45° field of view · fundus photo: 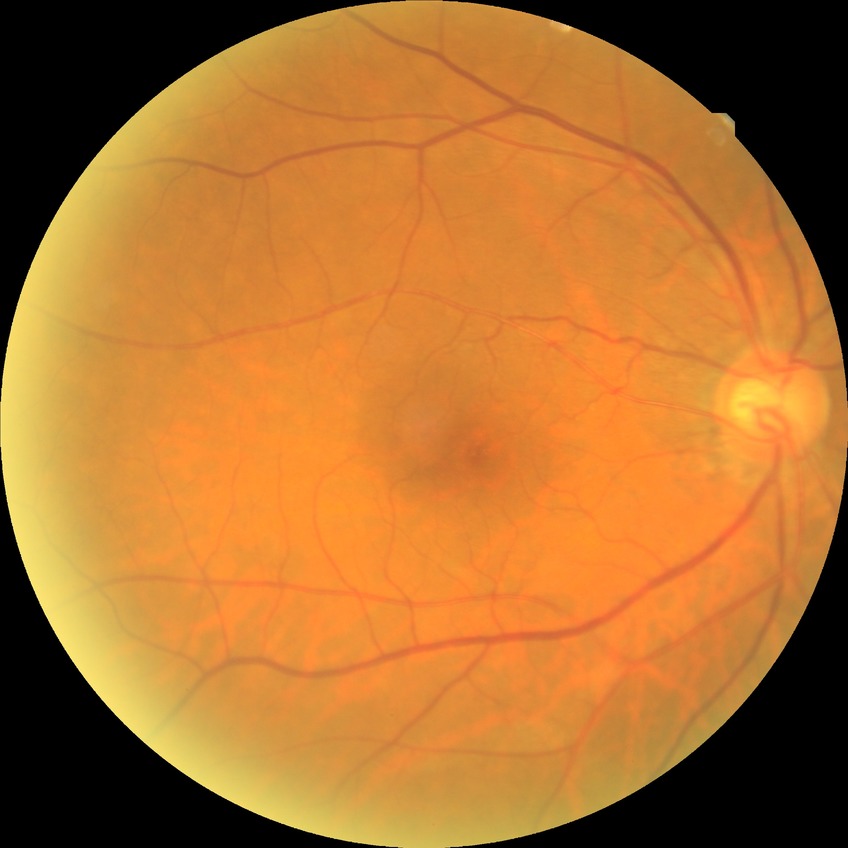

Diabetic retinopathy (DR): no diabetic retinopathy (NDR).